Phoenix ICON wide-field infant fundus image. 1240x1240.
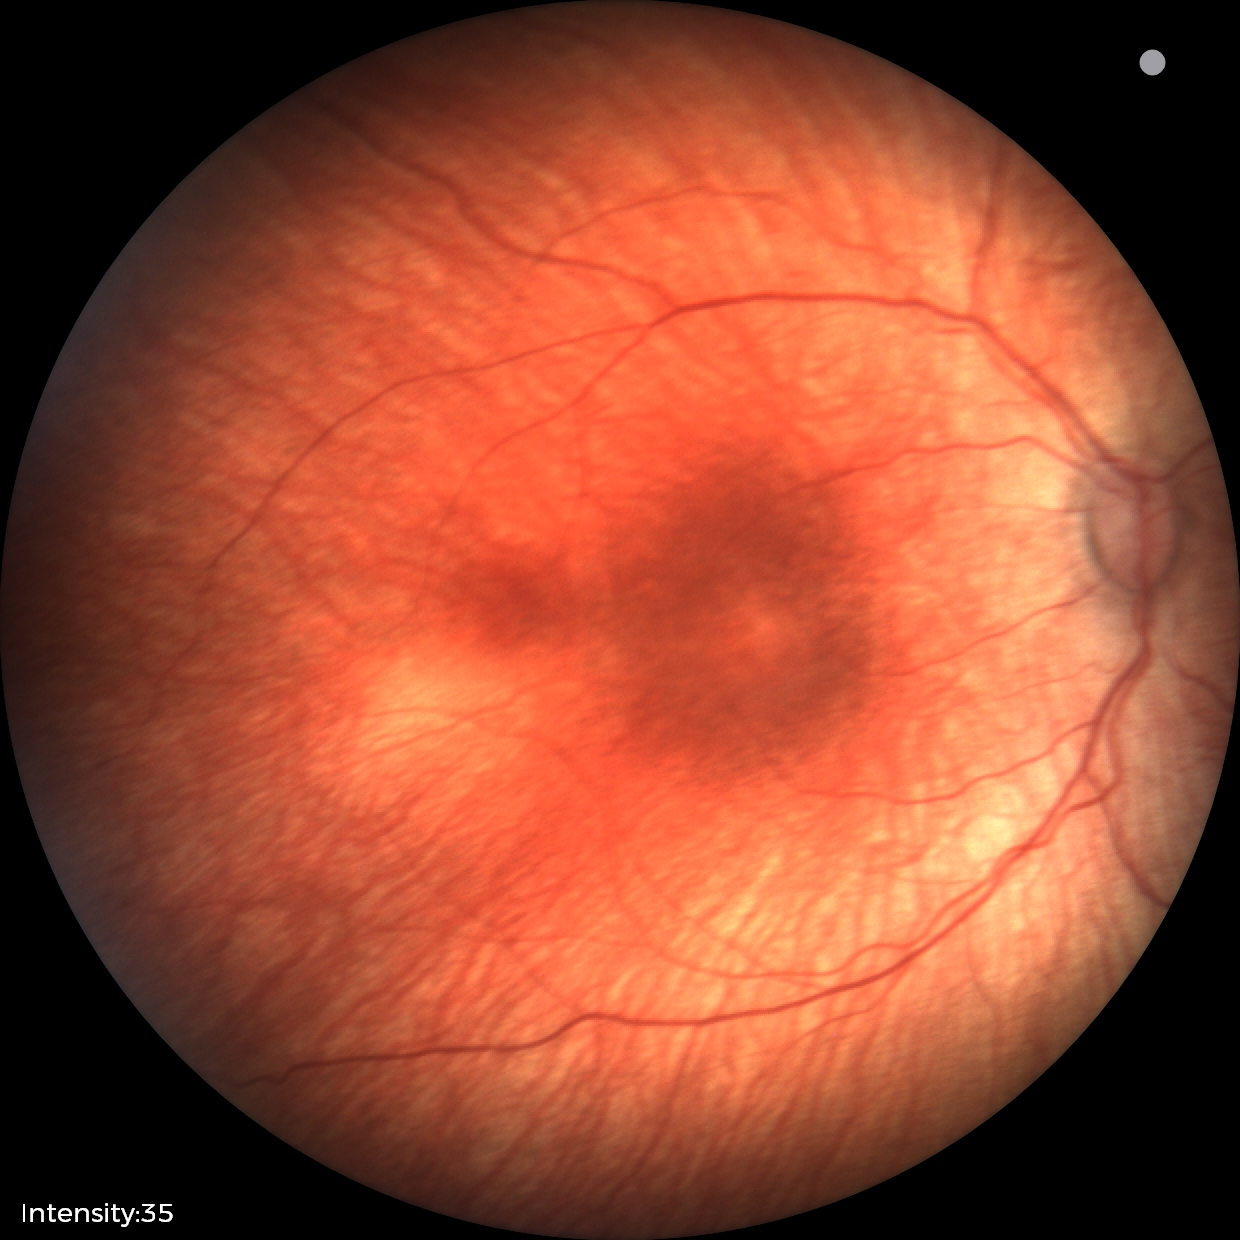

Finding: status post retinopathy of prematurity